Captured with the Clarity RetCam 3 (130° field of view). Pediatric wide-field fundus photograph. 640 x 480 pixels
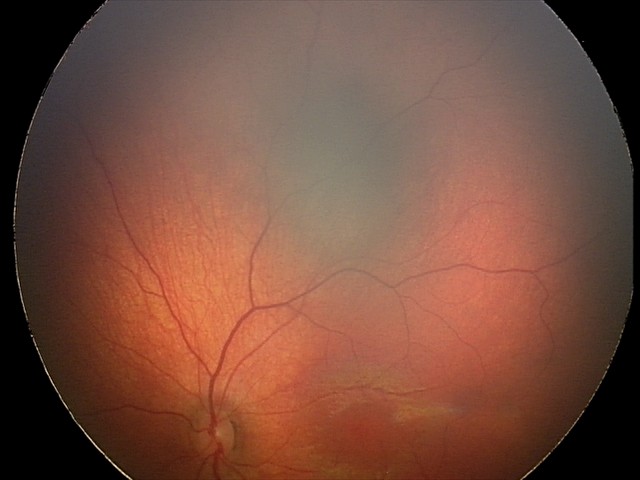

Screening series with retinal hemorrhages.